Nonmydriatic
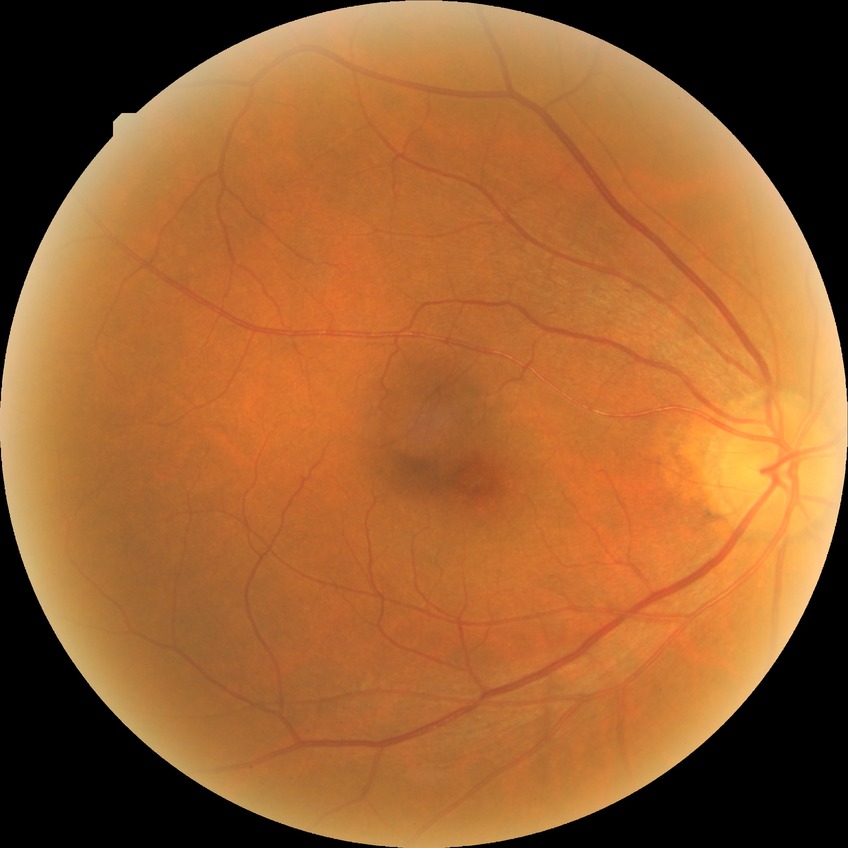 Diabetic retinopathy severity is no diabetic retinopathy.